Graded on the modified Davis scale, NIDEK AFC-230, no pharmacologic dilation, 848 by 848 pixels, posterior pole color fundus photograph, 45° field of view.
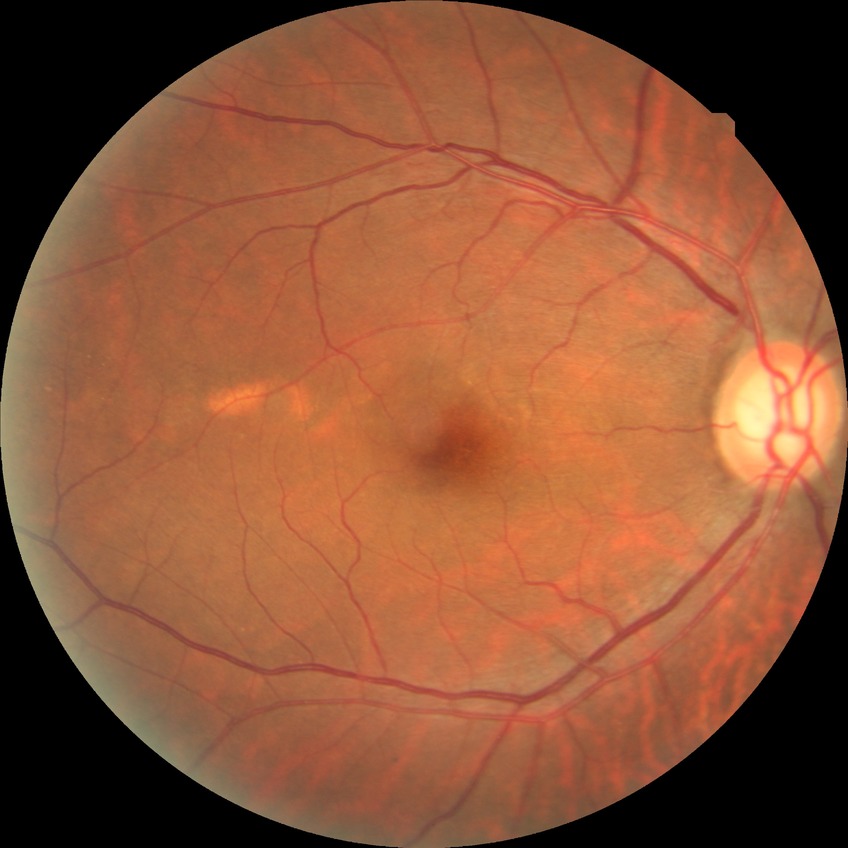 {"davis_grade": "no diabetic retinopathy"}